640x480px. Acquired on the Clarity RetCam 3. Wide-field fundus image from infant ROP screening — 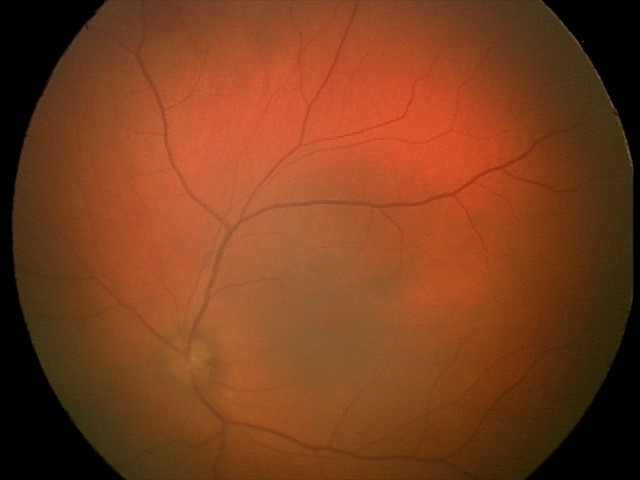

Series diagnosed as retinal hemorrhages.